No pharmacologic dilation; 45-degree field of view; modified Davis grading; 848x848px — 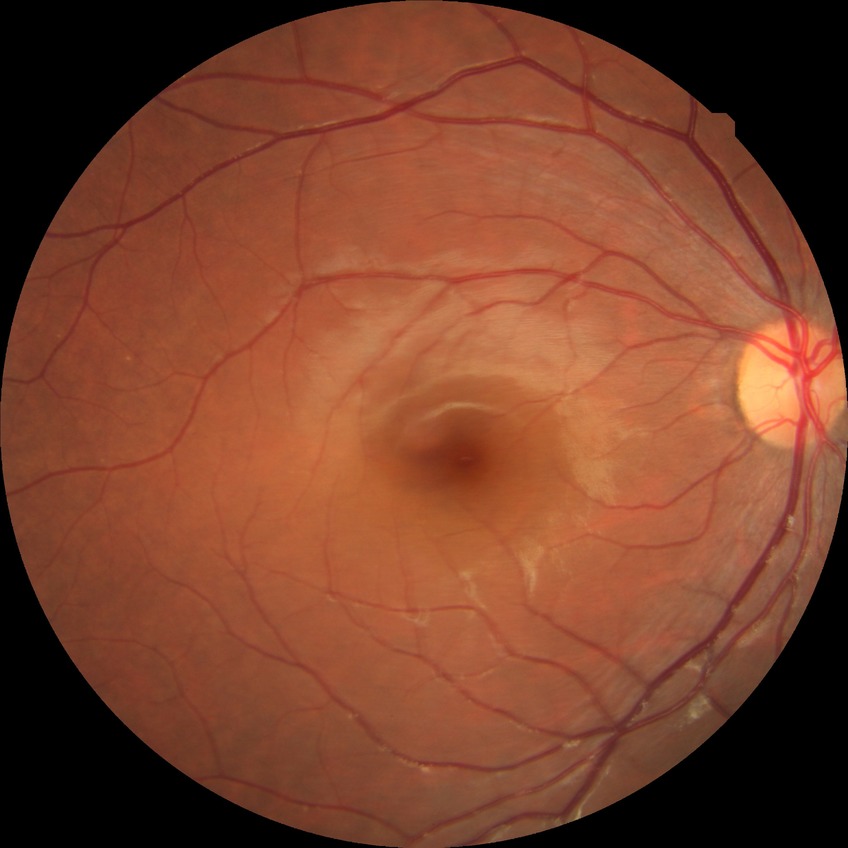 Davis DR grade: NDR.